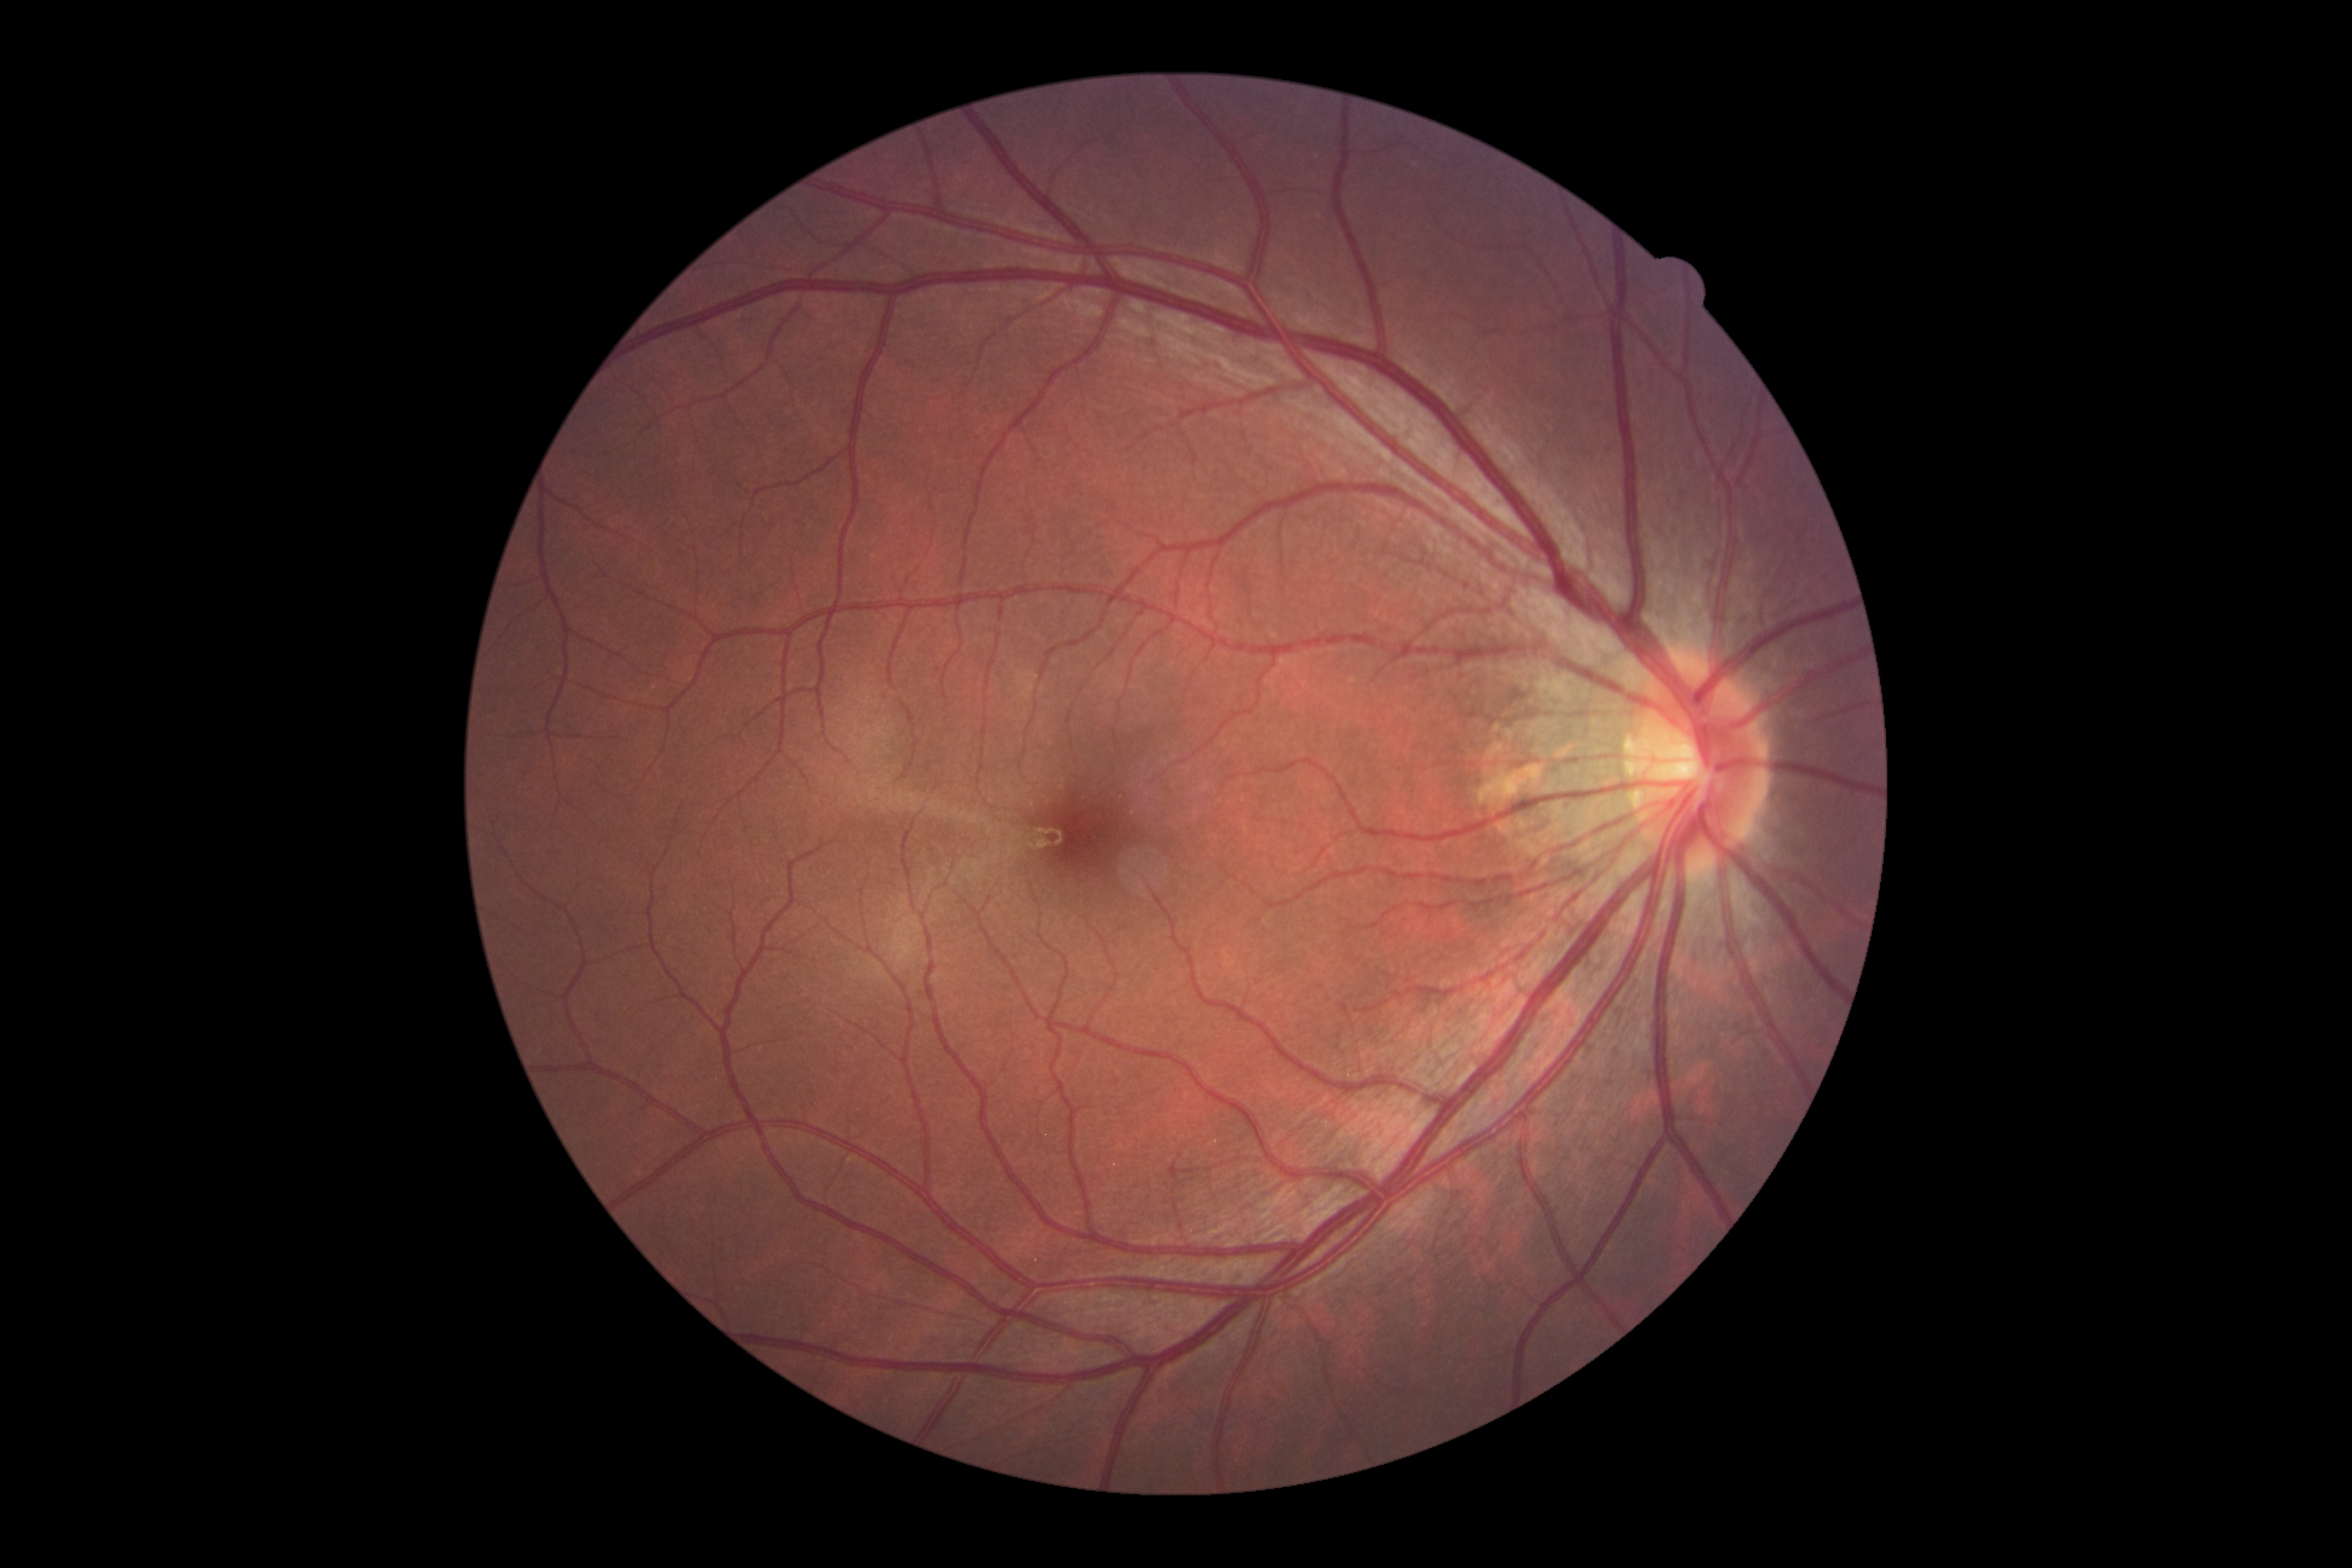 DR severity: grade 0 (no apparent retinopathy).